Retinal fundus photograph
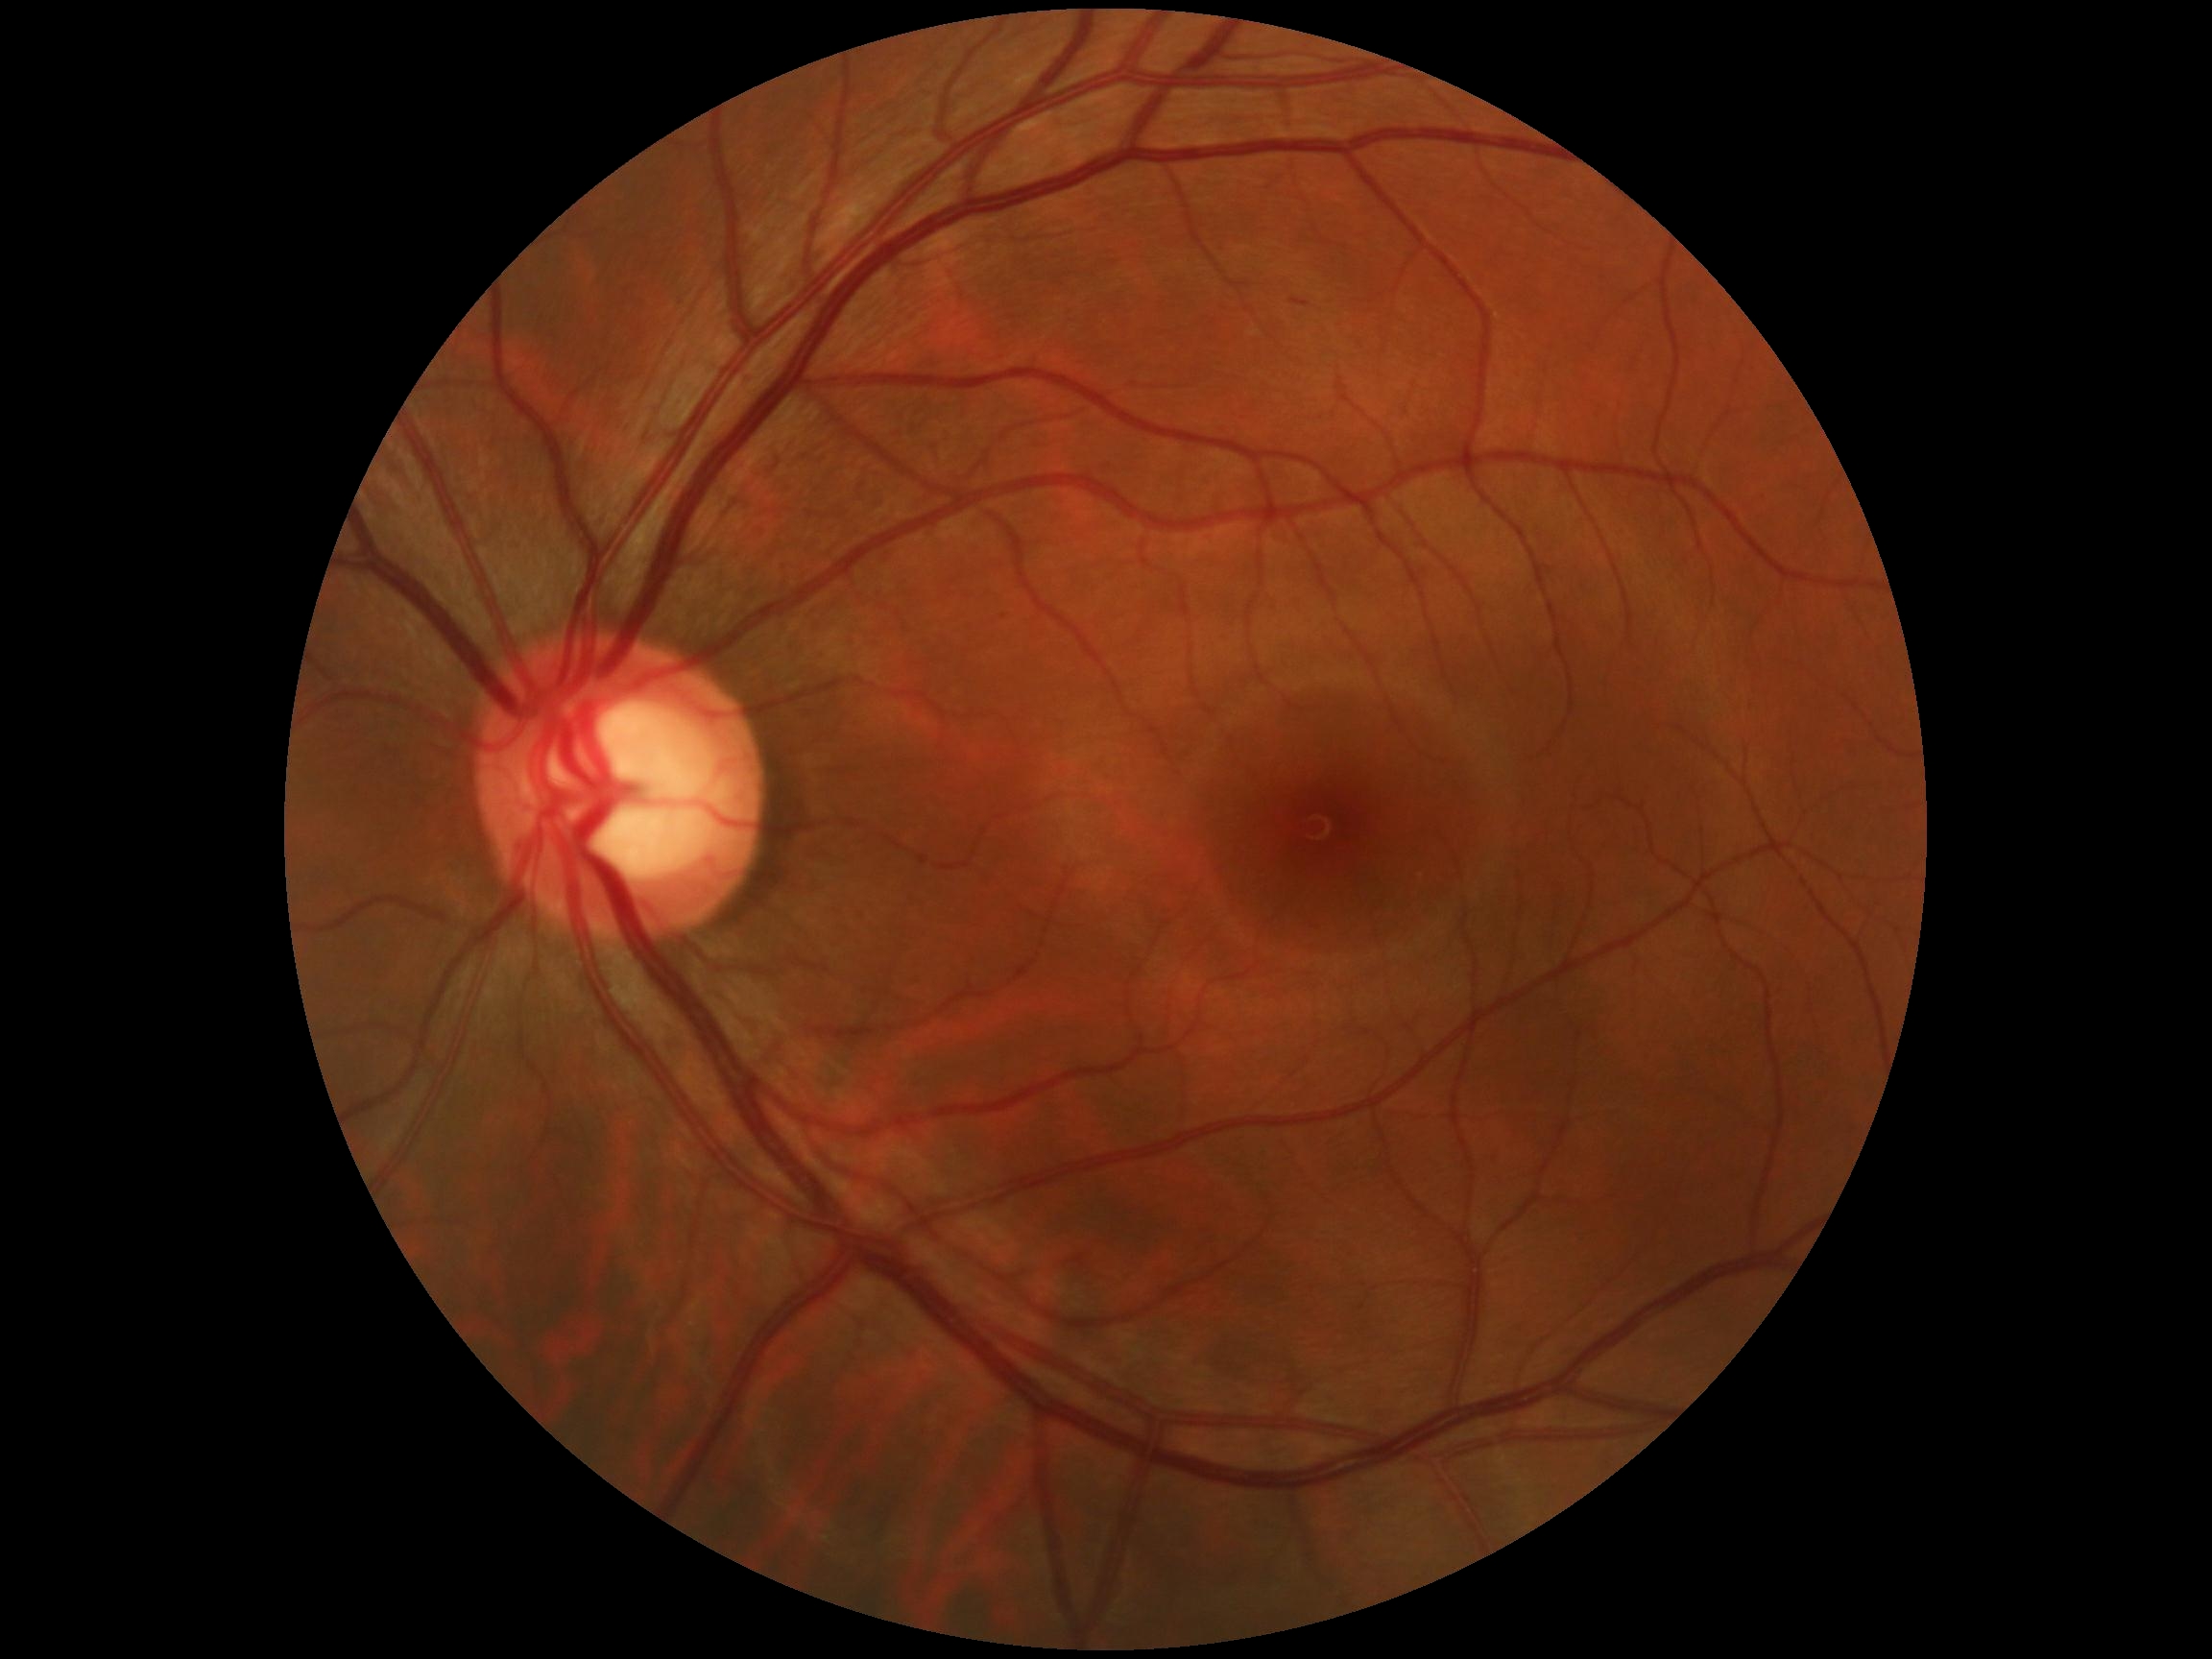 Retinopathy: 0/4 — no visible signs of diabetic retinopathy.